Acquired on the Clarity RetCam 3 · wide-field fundus photograph of an infant — 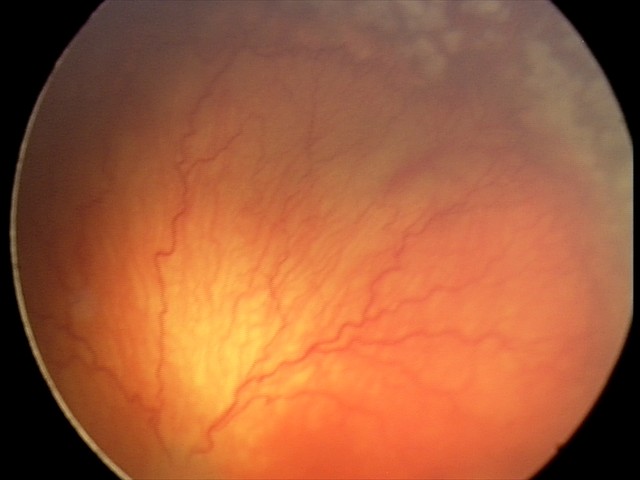
Diagnosis from this screening exam: aggressive retinopathy of prematurity — rapidly progressive severe ROP with prominent plus disease, often without classic stage progression. Plus disease was diagnosed.